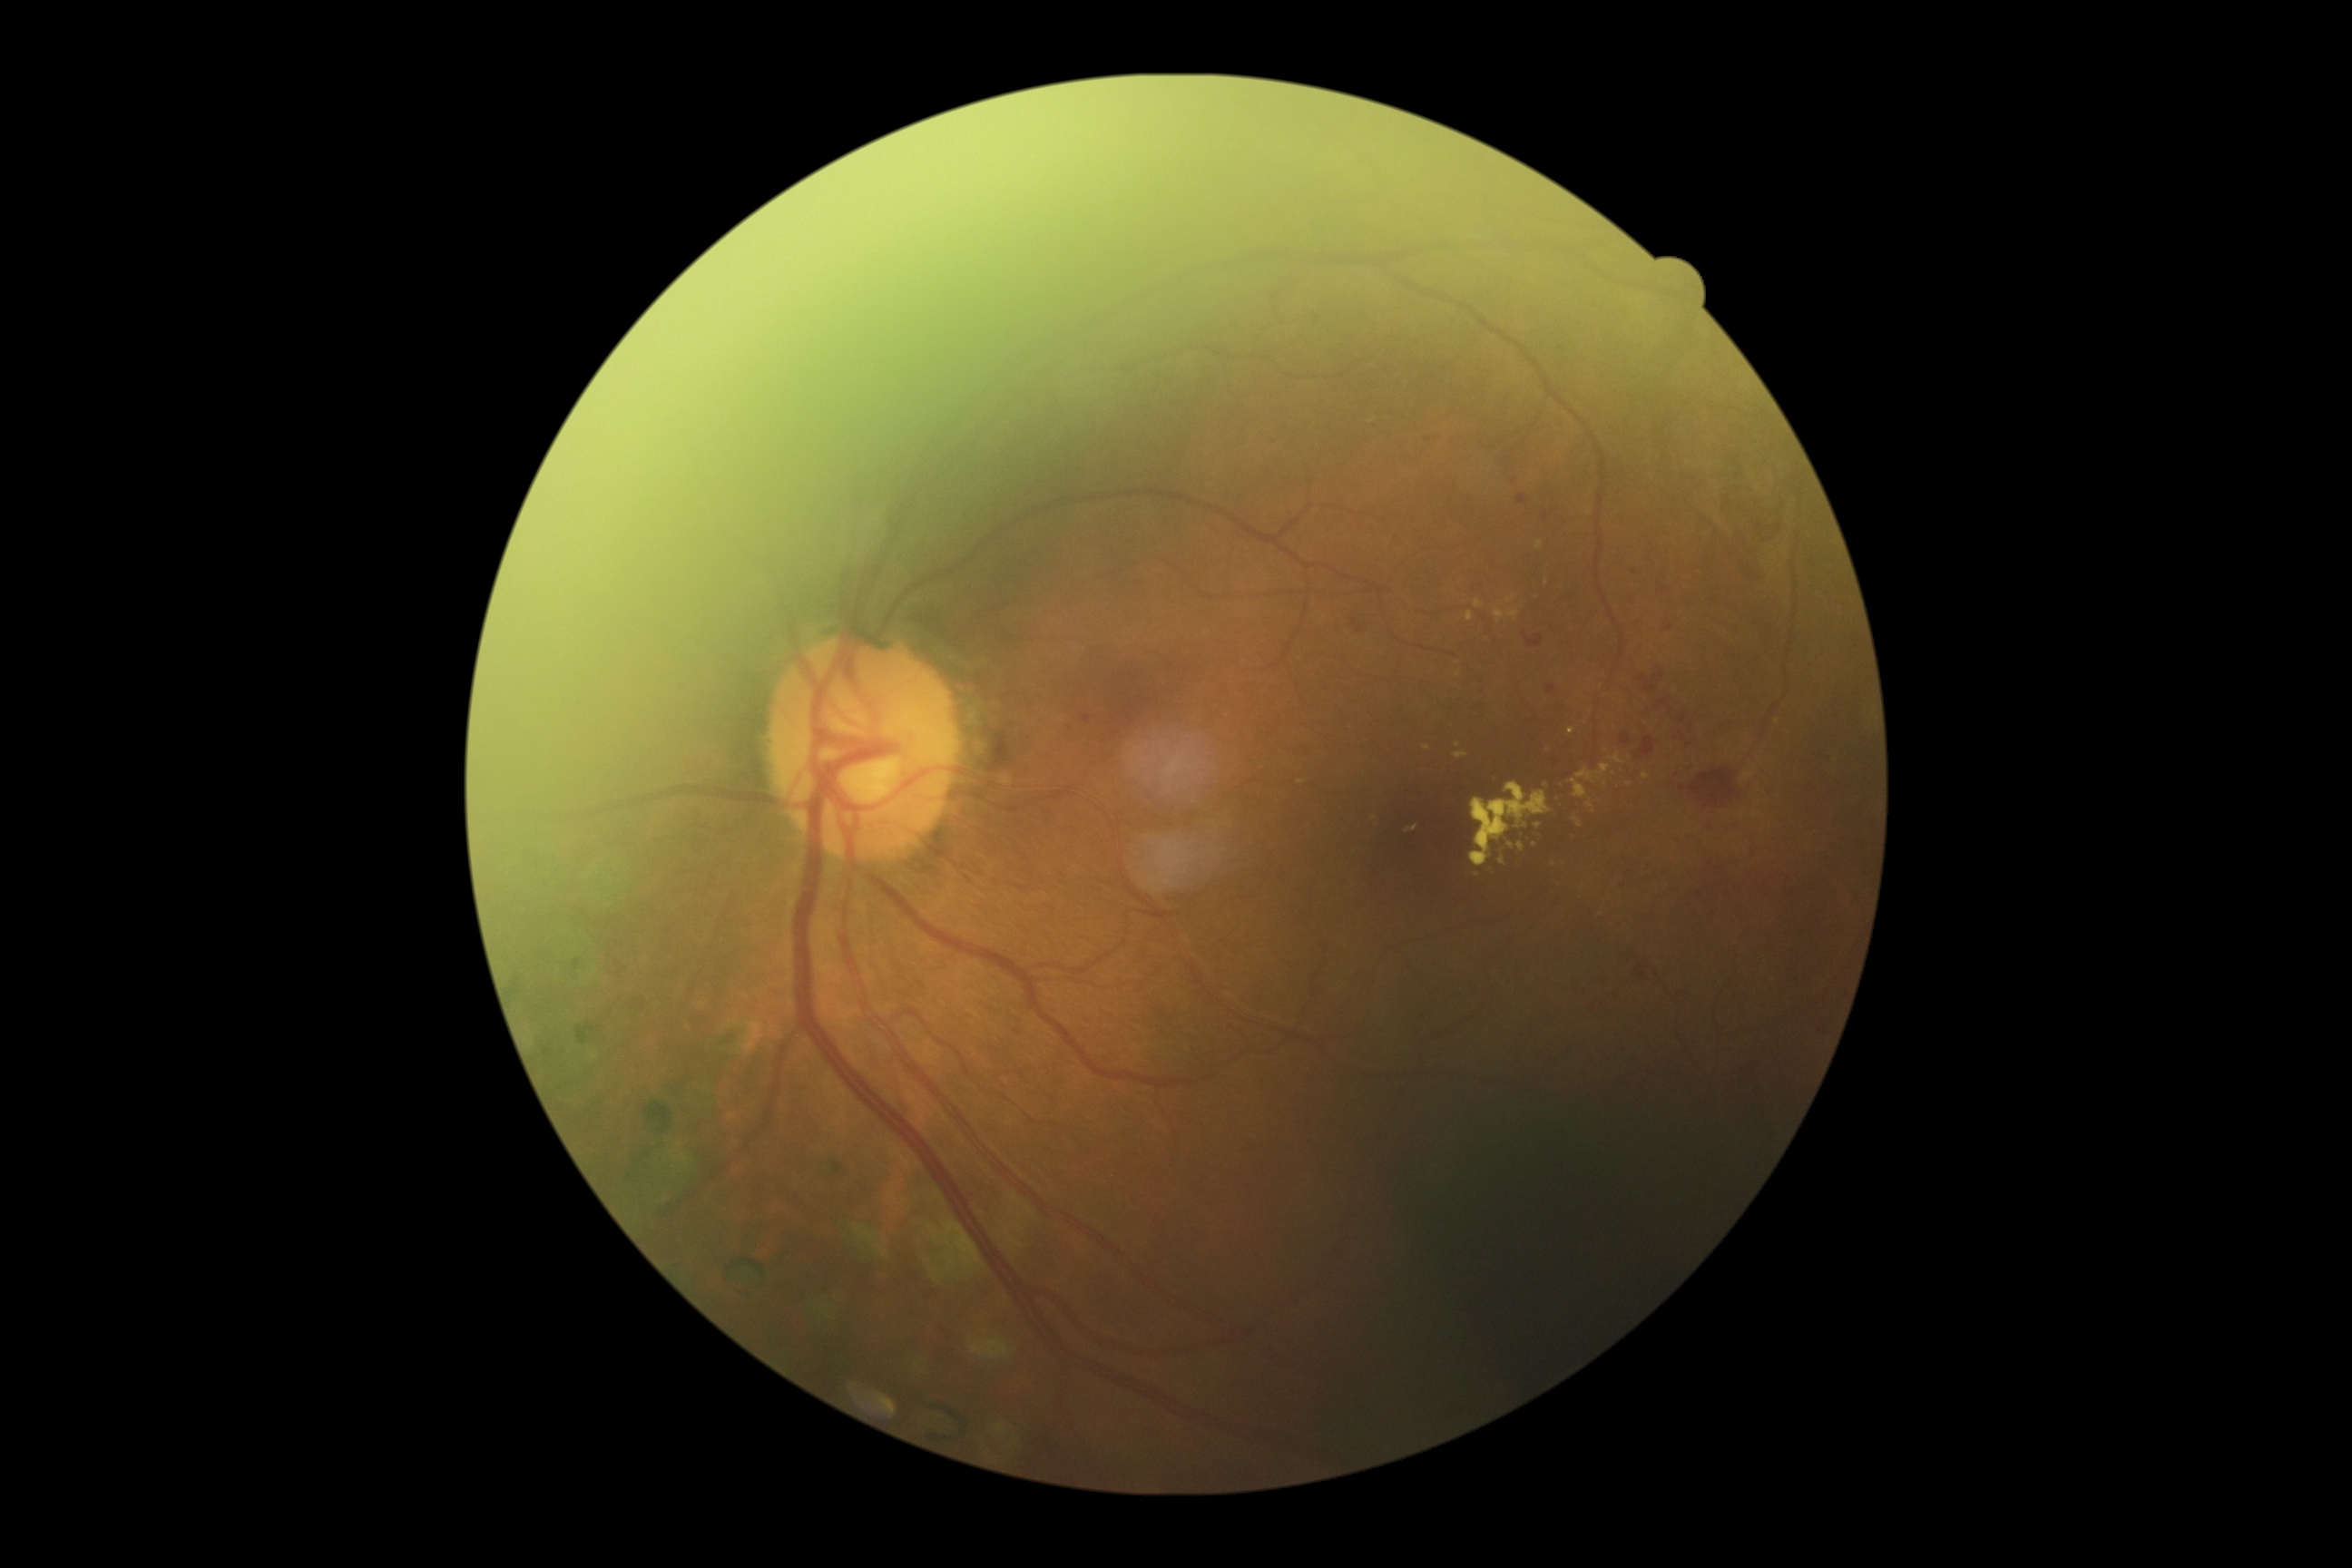

DR severity is grade 2. The retinopathy is classified as non-proliferative diabetic retinopathy.